45° FOV, 2048x1536
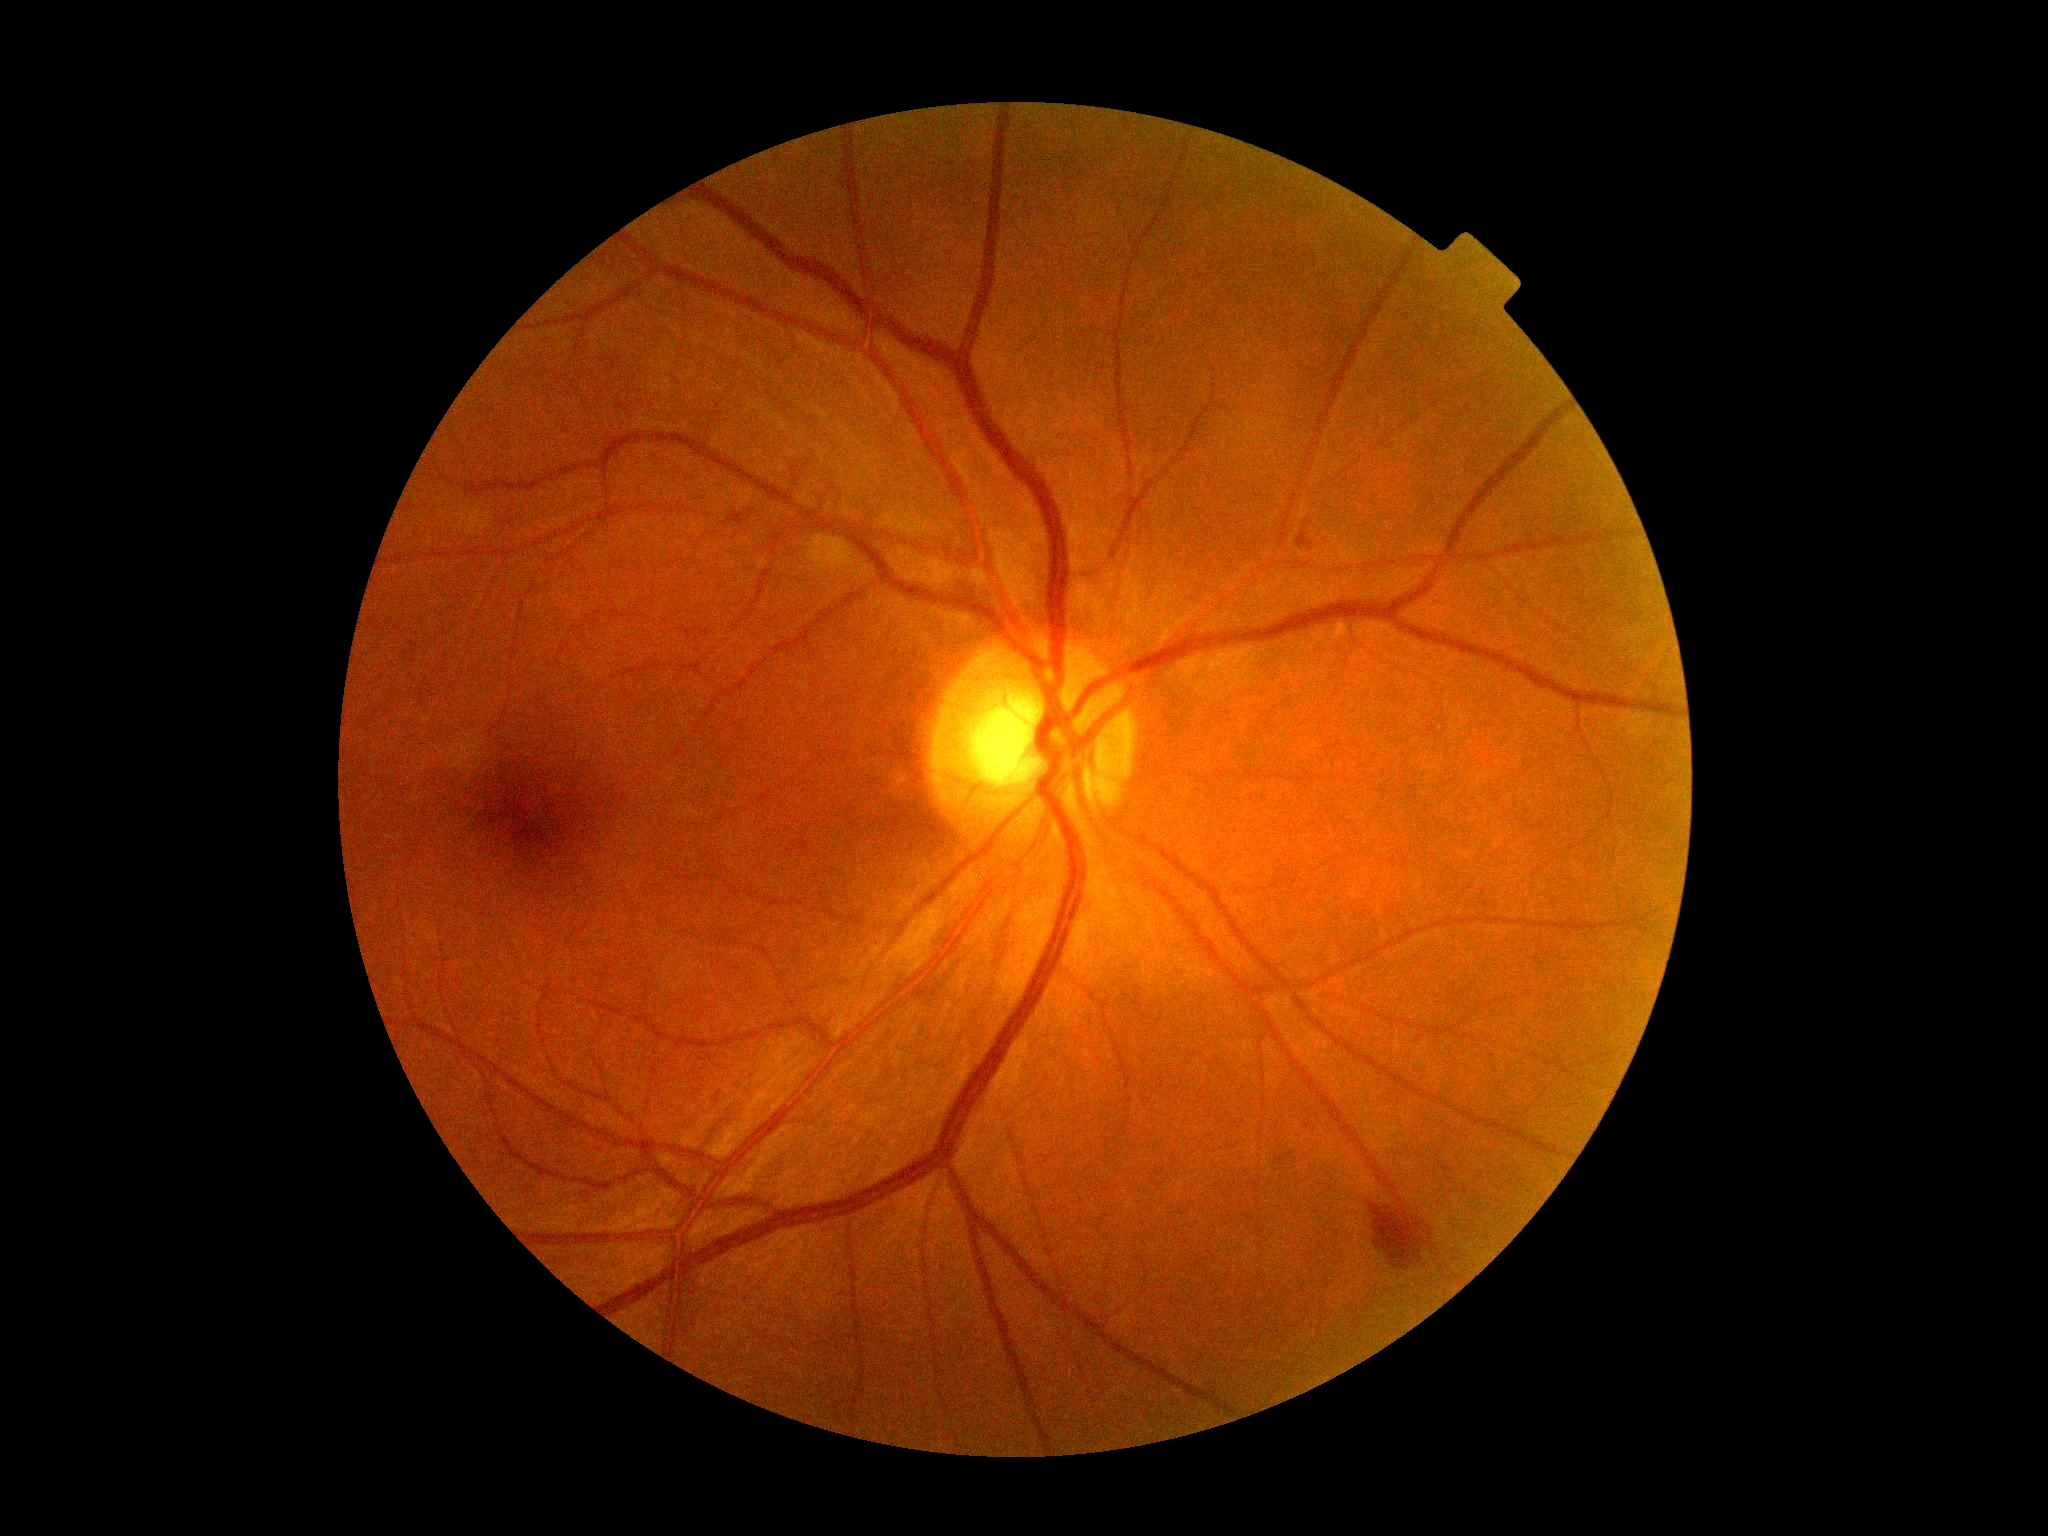

DR: grade 2.